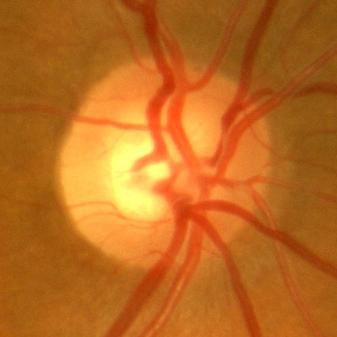
Q: Is there glaucomatous optic neuropathy?
A: No — no signs of glaucoma.